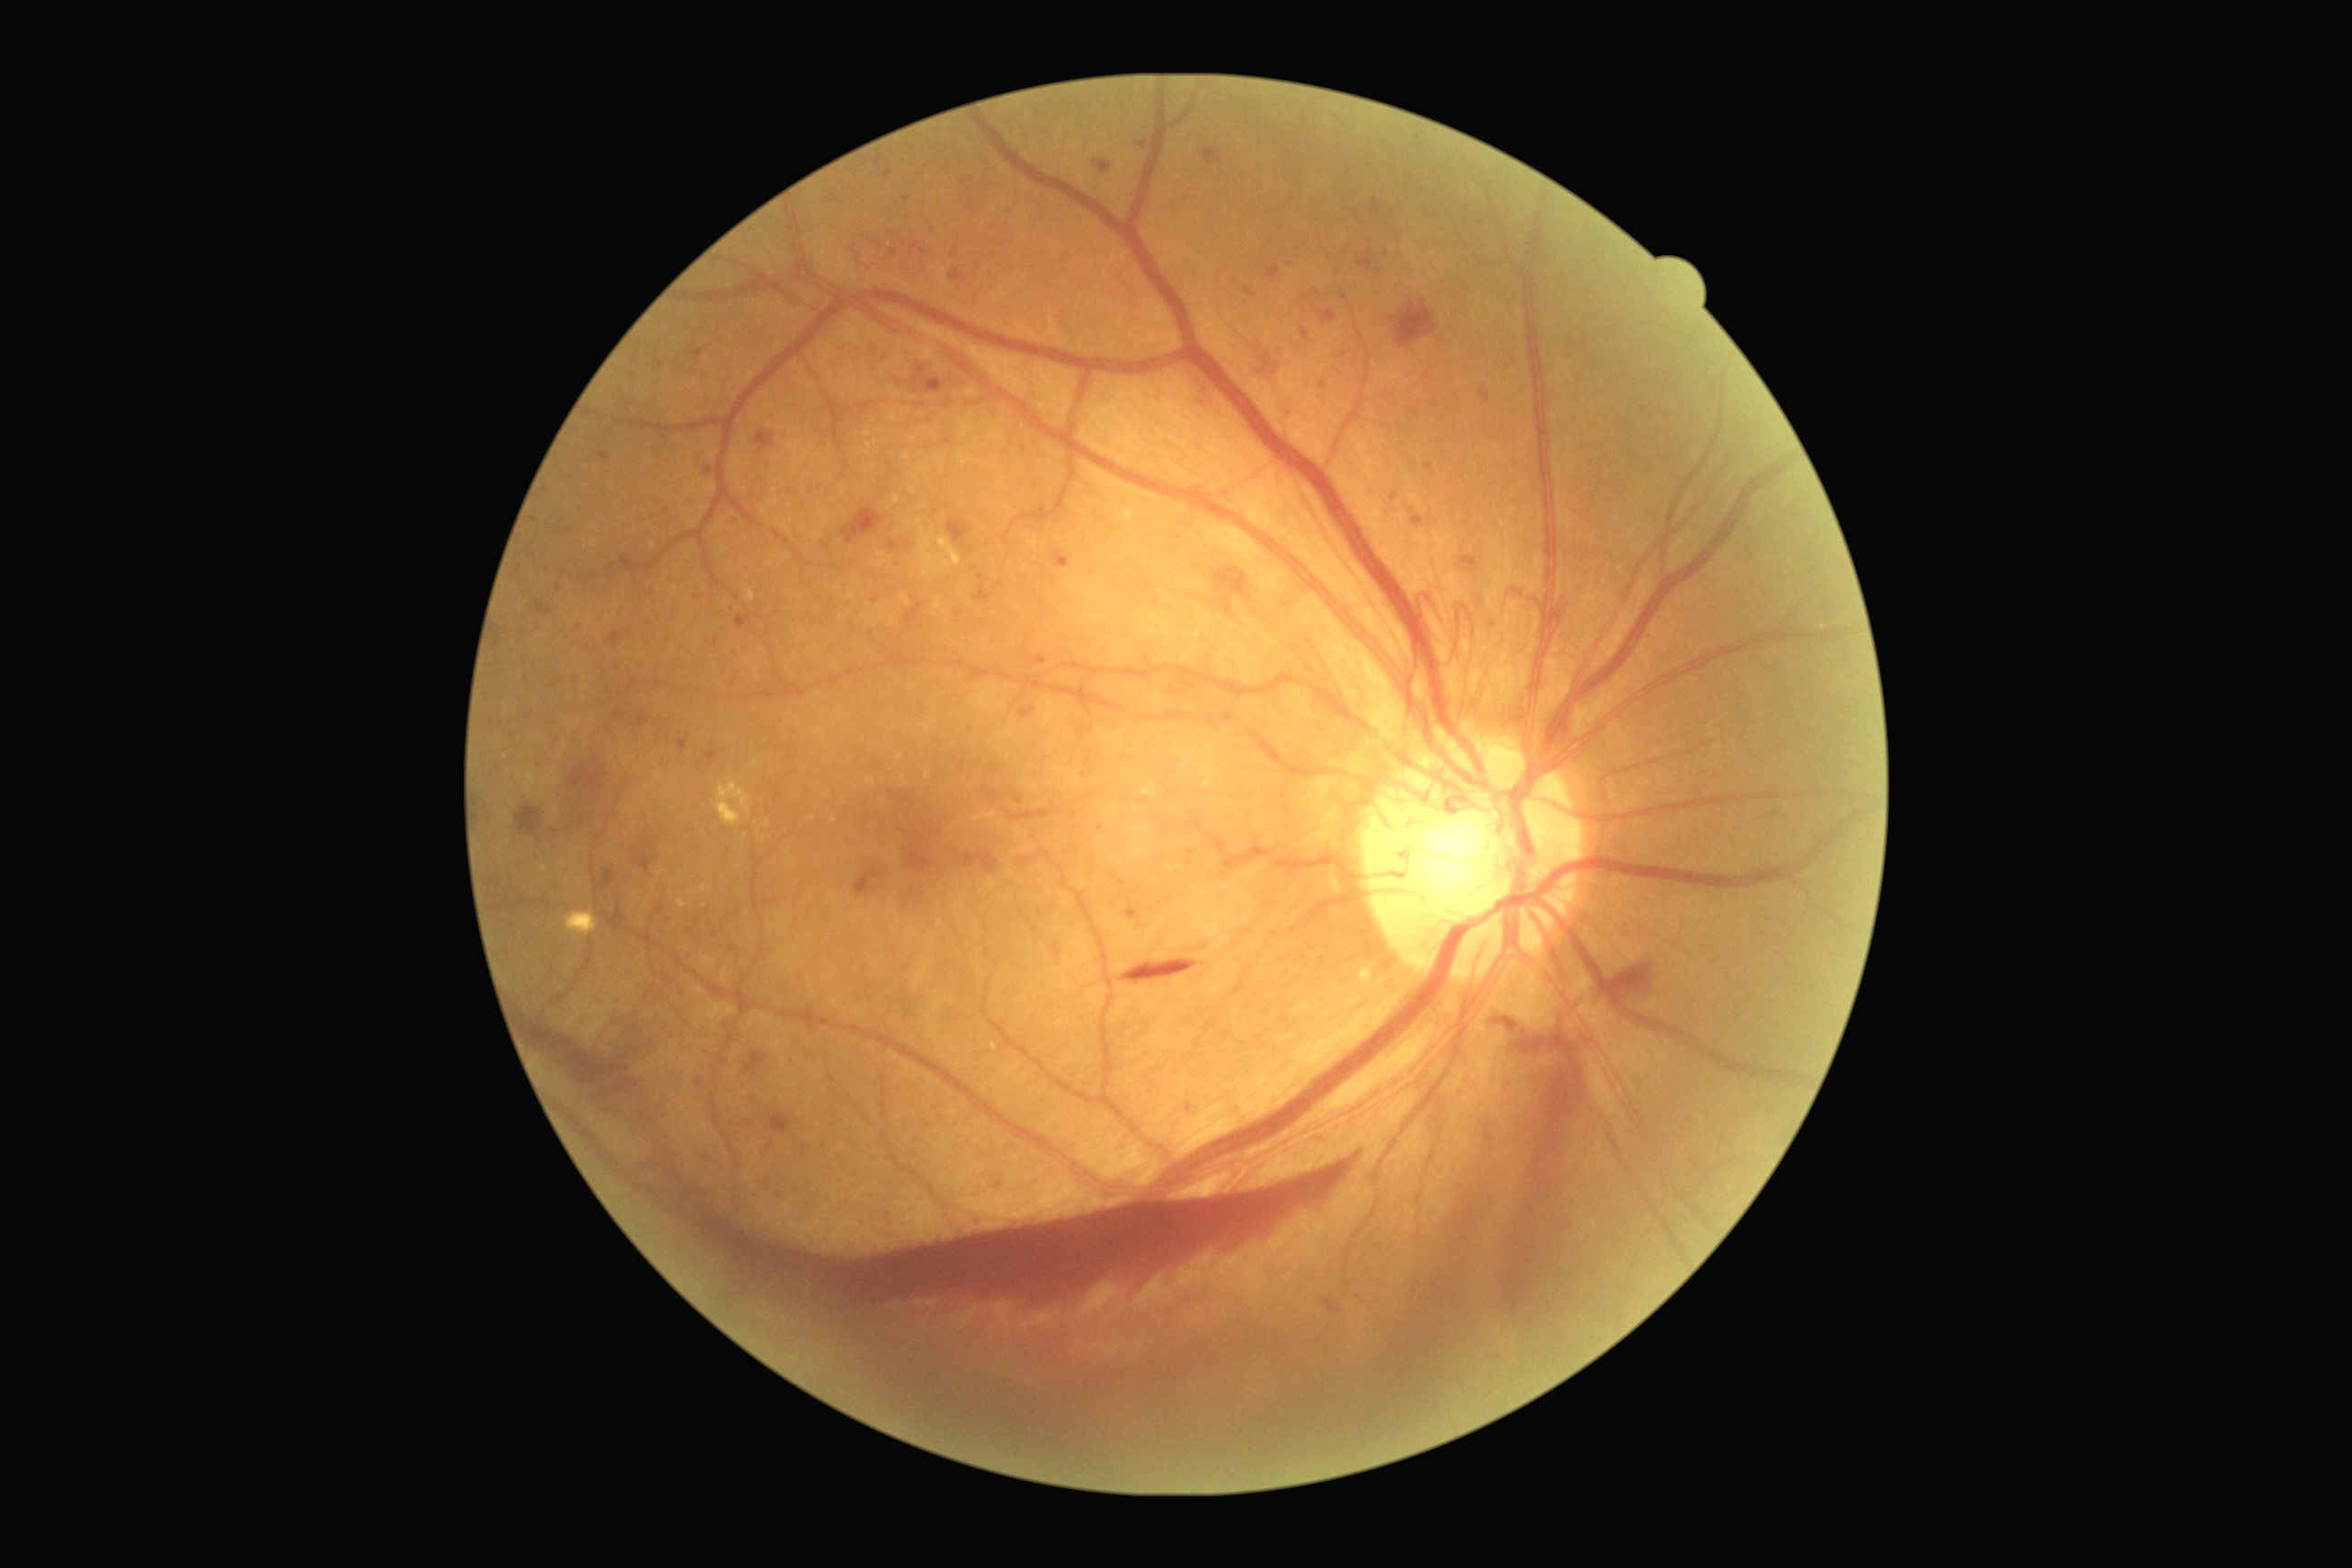 Diabetic retinopathy (DR) is grade 4 (PDR).
Microaneurysms (MAs) (partial list) at 1304, 291, 1322, 302 | 1357, 257, 1373, 271 | 883, 168, 894, 181 | 1300, 328, 1309, 342 | 1280, 1017, 1289, 1023 | 1313, 309, 1338, 324 | 692, 349, 705, 362 | 1391, 493, 1398, 502 | 945, 438, 950, 446 | 703, 467, 714, 476 | 1320, 382, 1328, 389.
Small MAs near {"x": 697, "y": 597} | {"x": 1381, "y": 273} | {"x": 661, "y": 366} | {"x": 1387, "y": 254} | {"x": 771, "y": 1148}.
Hemorrhages (HEs) (partial list) at 1386, 1059, 1529, 1351 | 912, 364, 943, 395 | 1462, 556, 1478, 571 | 573, 770, 605, 790 | 1502, 1037, 1580, 1318 | 1322, 1297, 1344, 1315 | 948, 520, 972, 545 | 963, 854, 999, 874 | 1119, 959, 1199, 985 | 1092, 161, 1112, 175 | 607, 901, 631, 934 | 770, 1112, 792, 1135 | 1015, 798, 1024, 805 | 950, 270, 966, 282 | 843, 507, 885, 545 | 756, 429, 776, 453 | 906, 603, 923, 623 | 1213, 567, 1250, 598.